Infant wide-field fundus photograph. Captured with the Natus RetCam Envision (130° field of view). 1440x1080px:
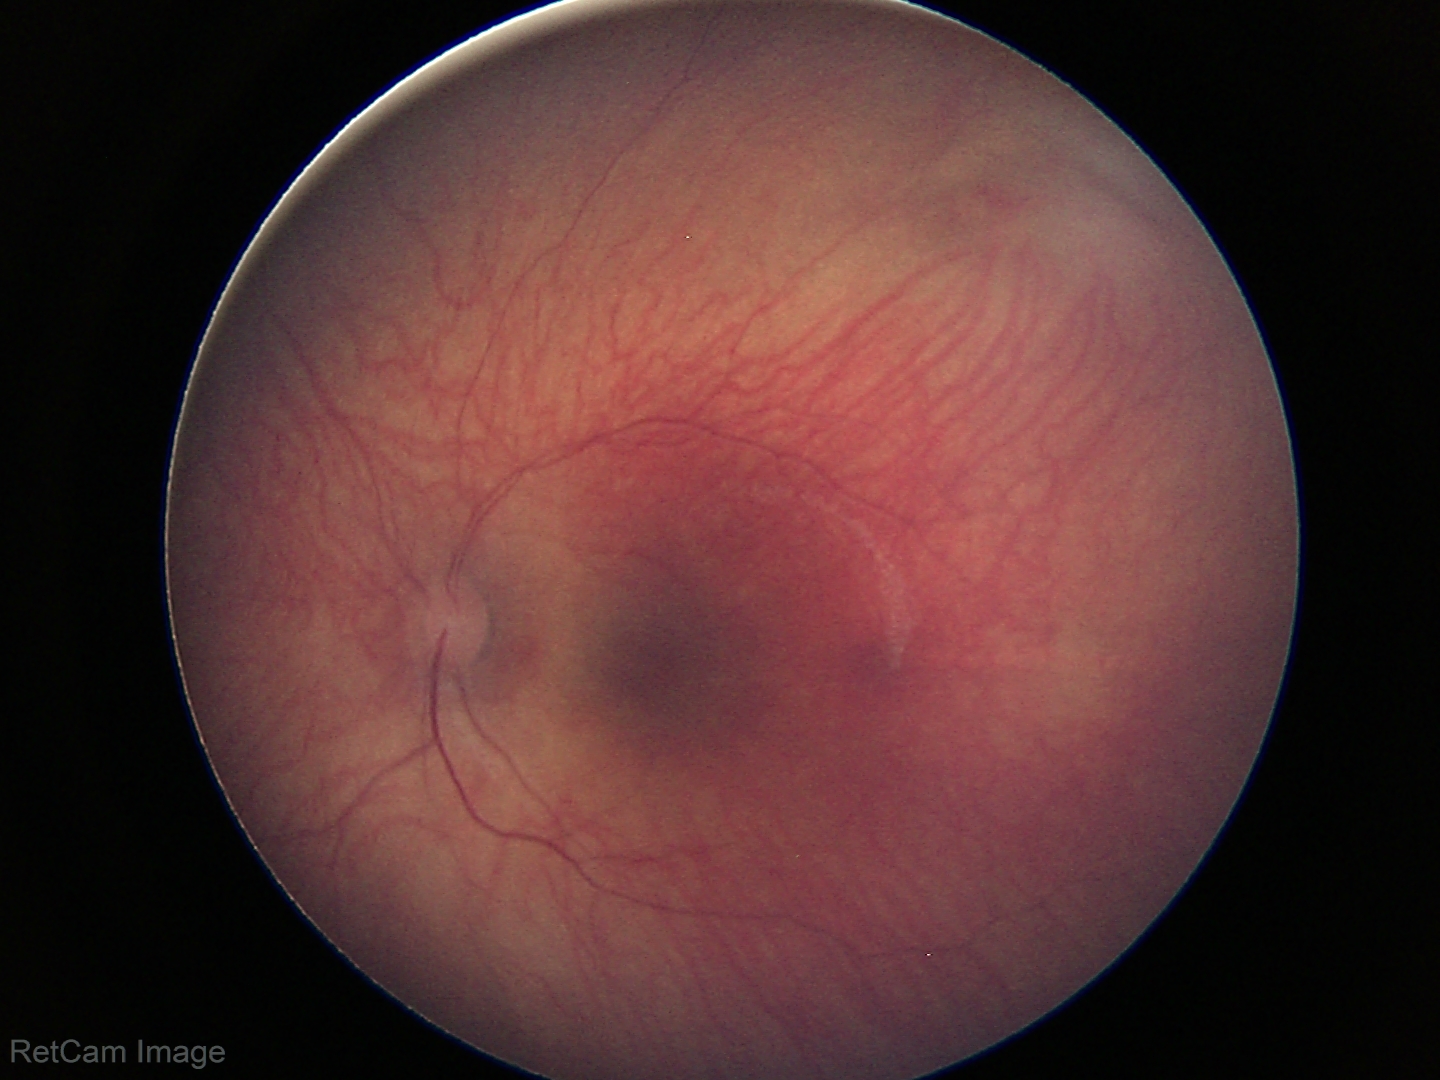

Assessment = physiological appearance